DR severity per modified Davis staging:
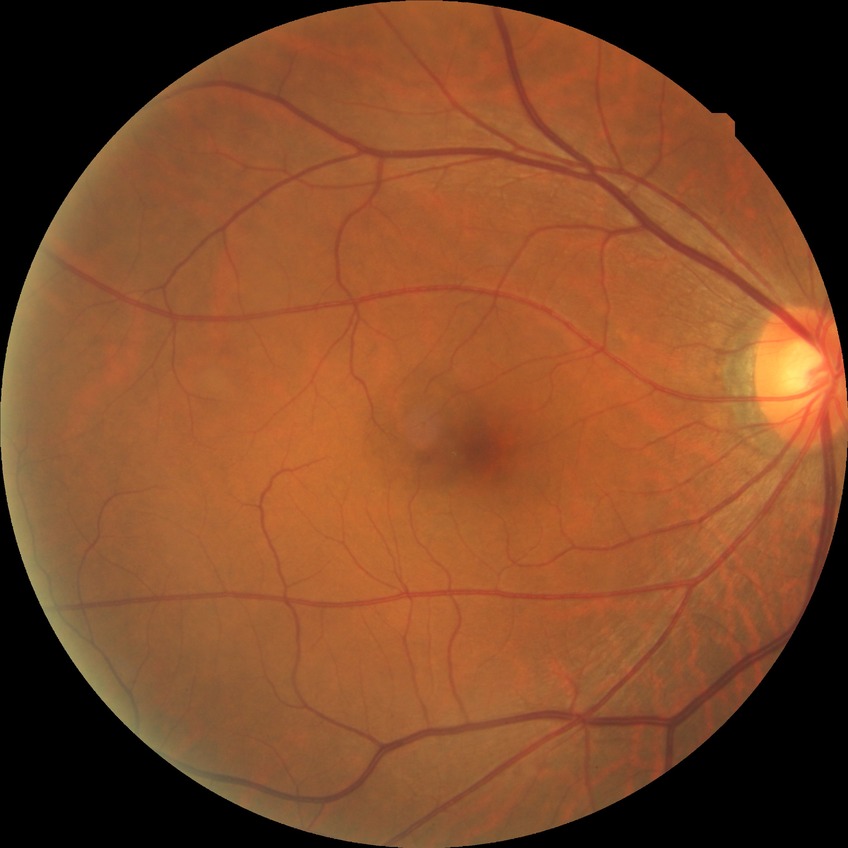

Retinopathy stage: no diabetic retinopathy.